Graded on the modified Davis scale. Nonmydriatic. Color fundus image.
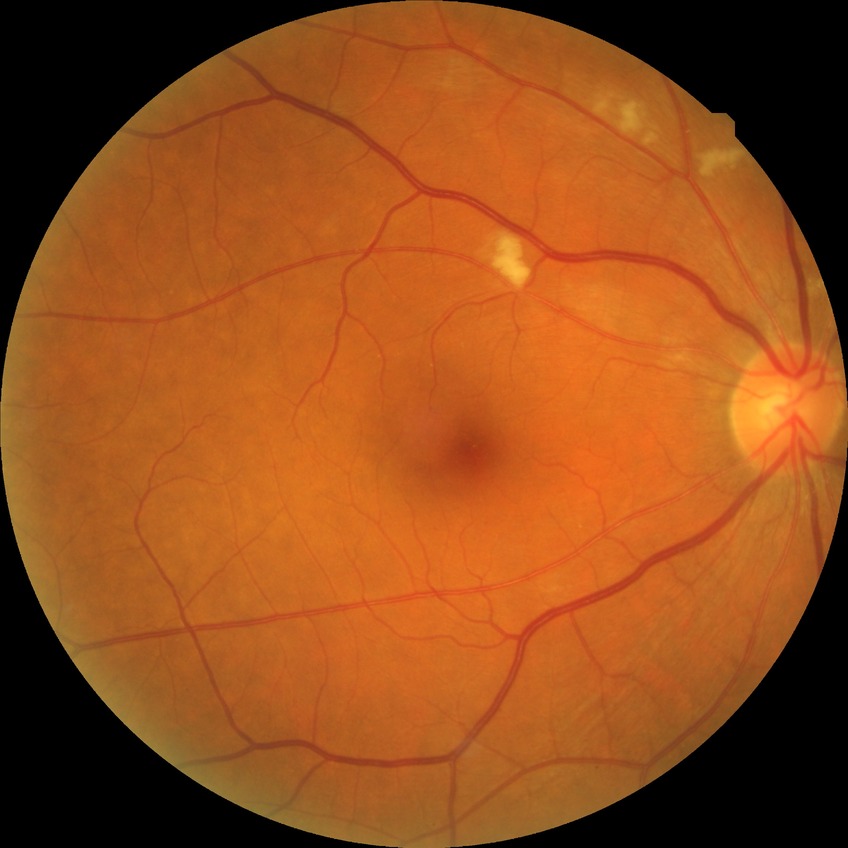
Diabetic retinopathy (DR) is NDR (no diabetic retinopathy).